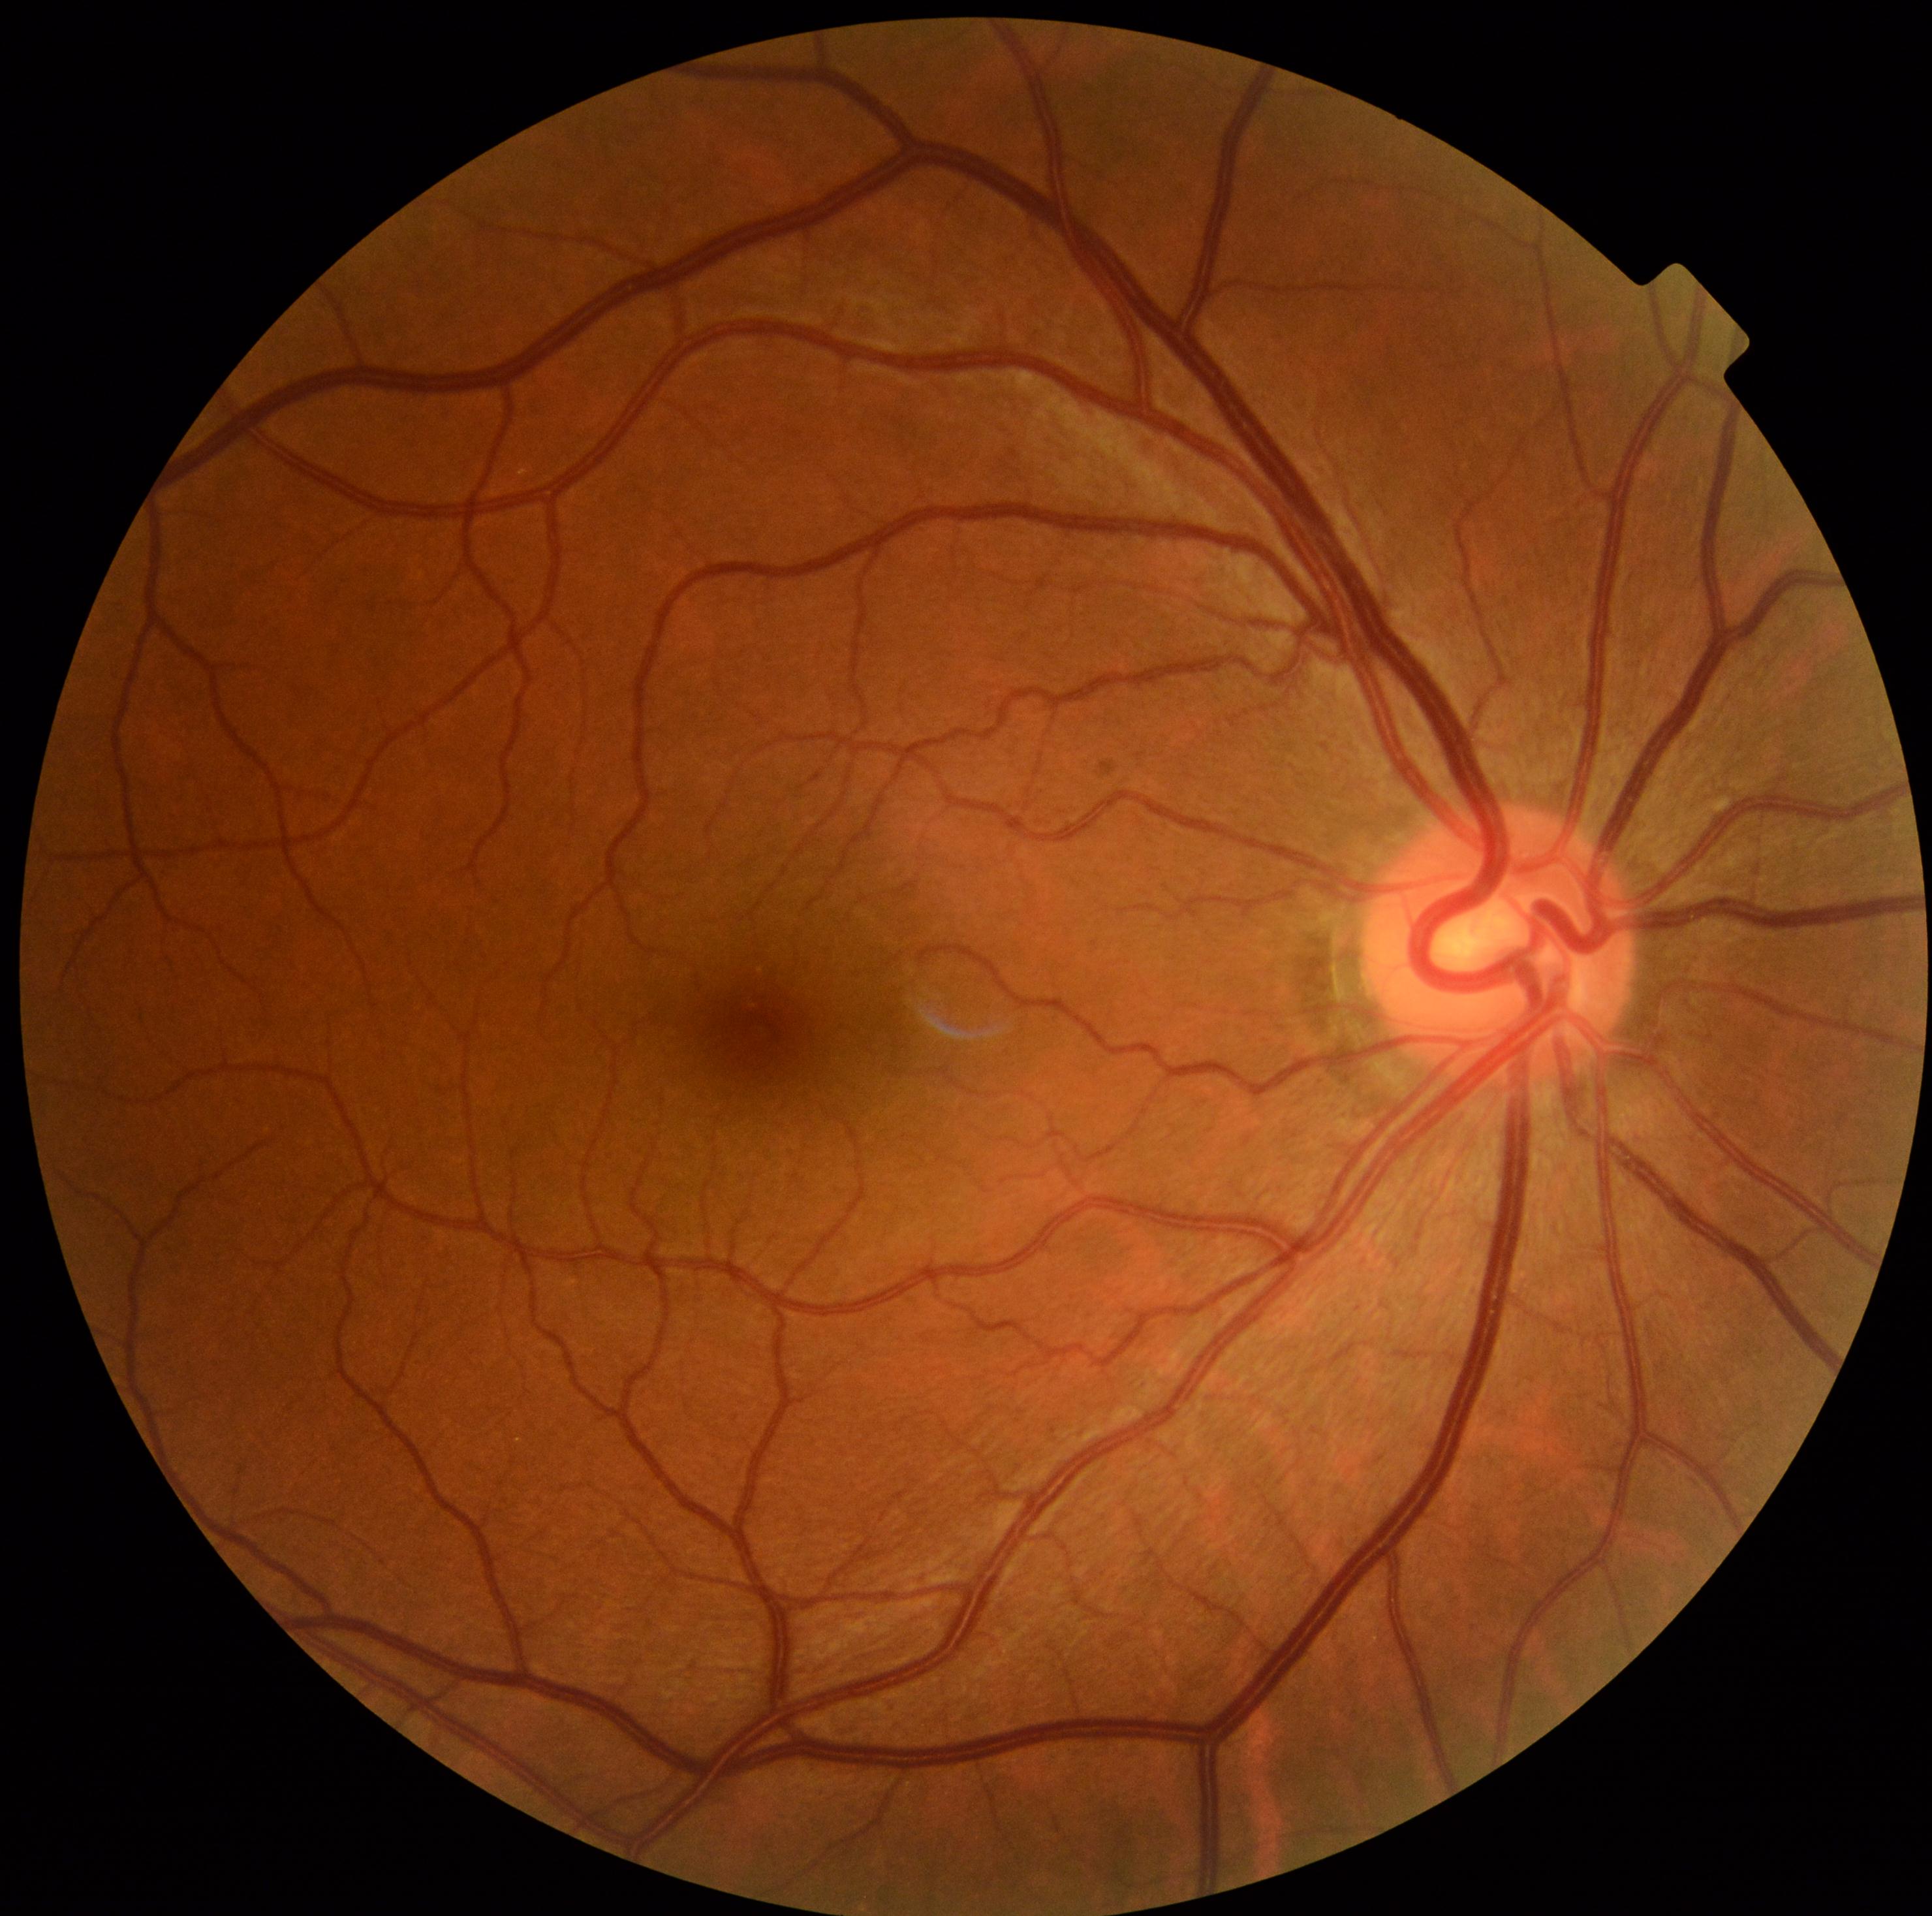
diabetic retinopathy = 0